NIDEK AFC-230 fundus camera, fundus photo — 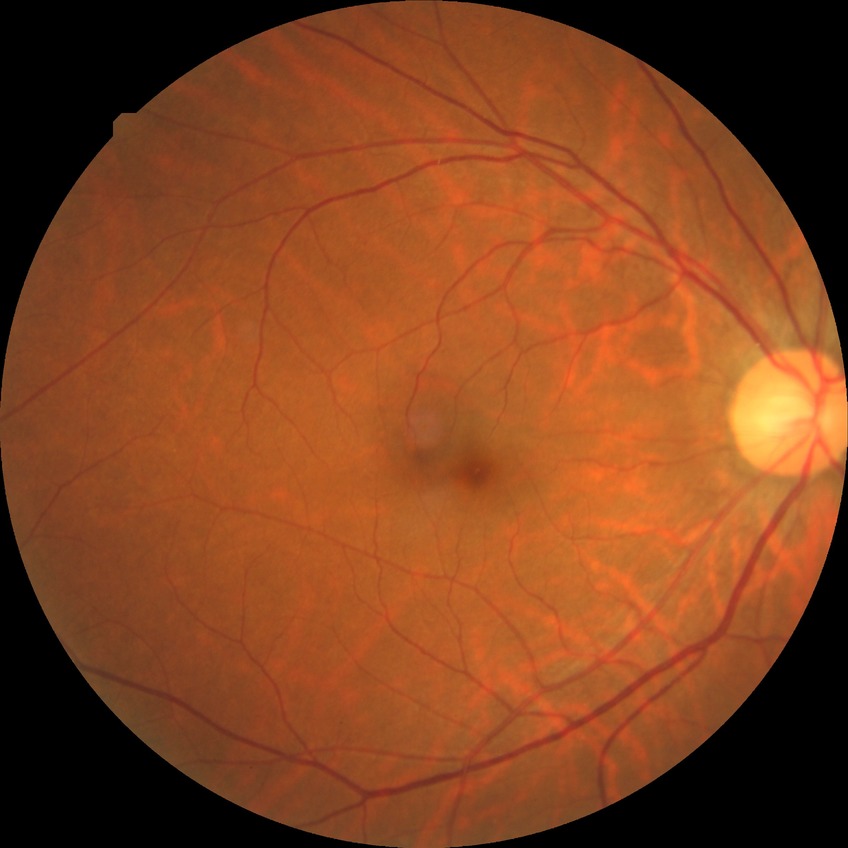 Diabetic retinopathy (DR) is NDR (no diabetic retinopathy).